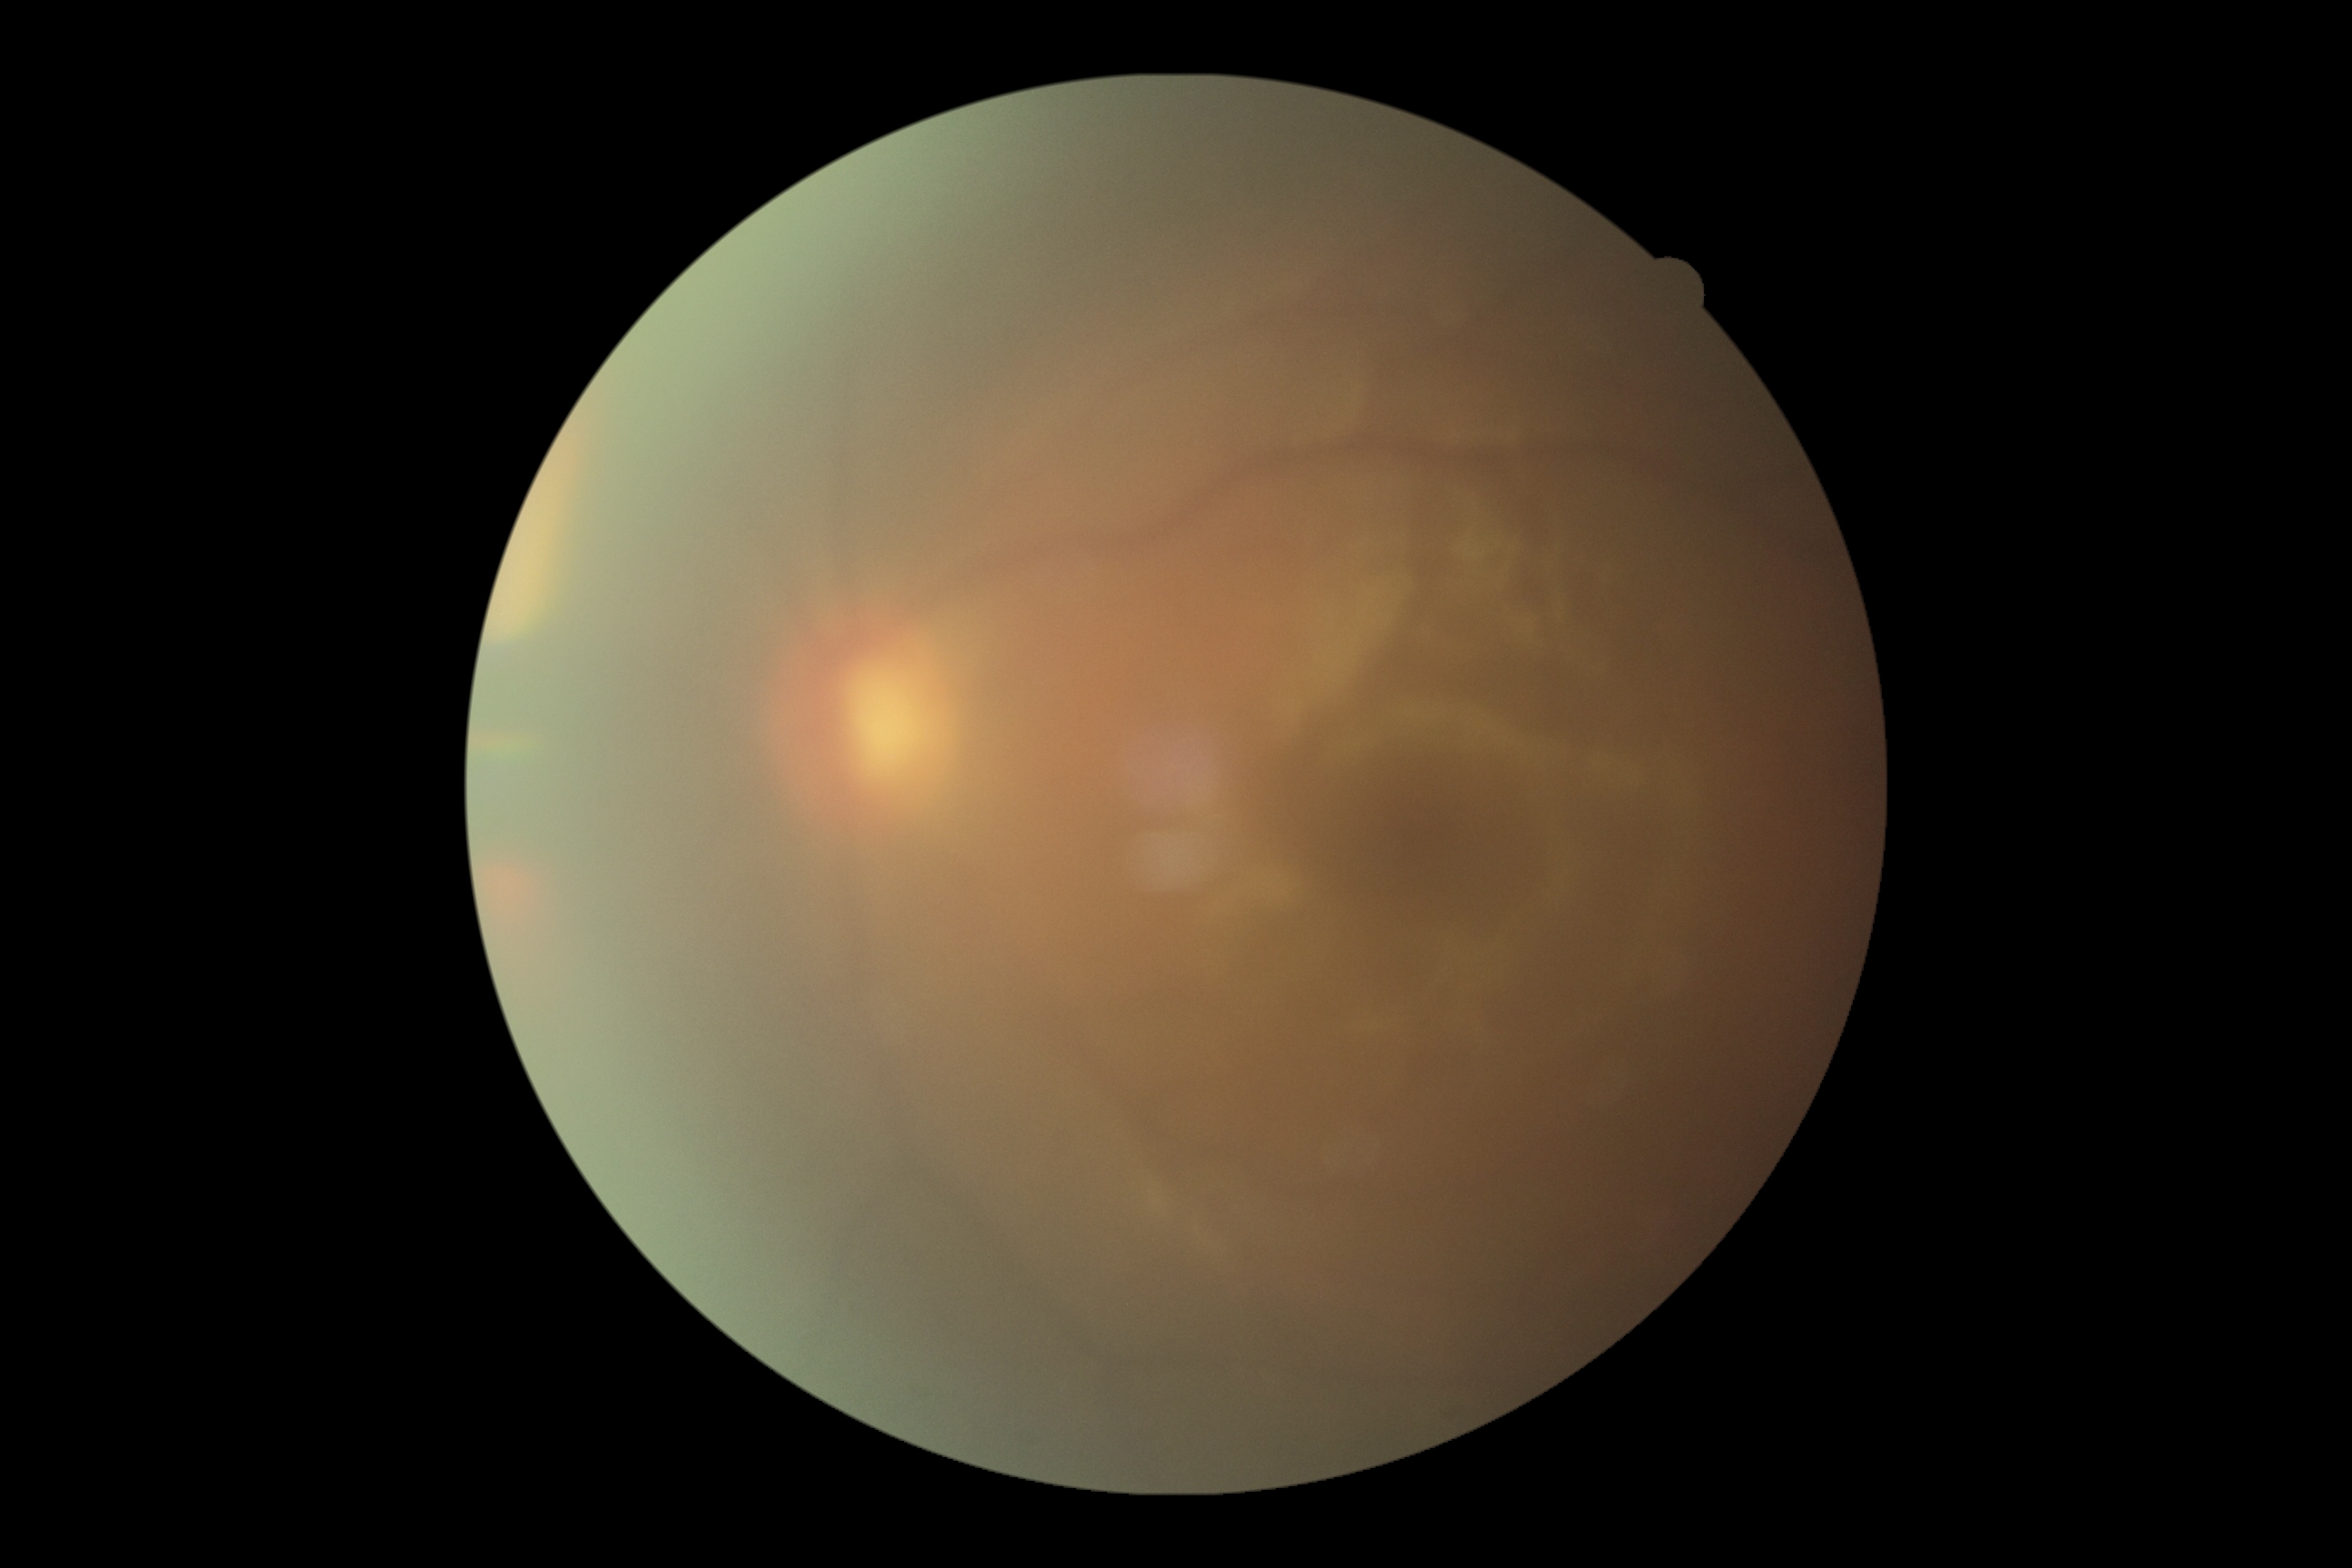

DR severity is ungradable.